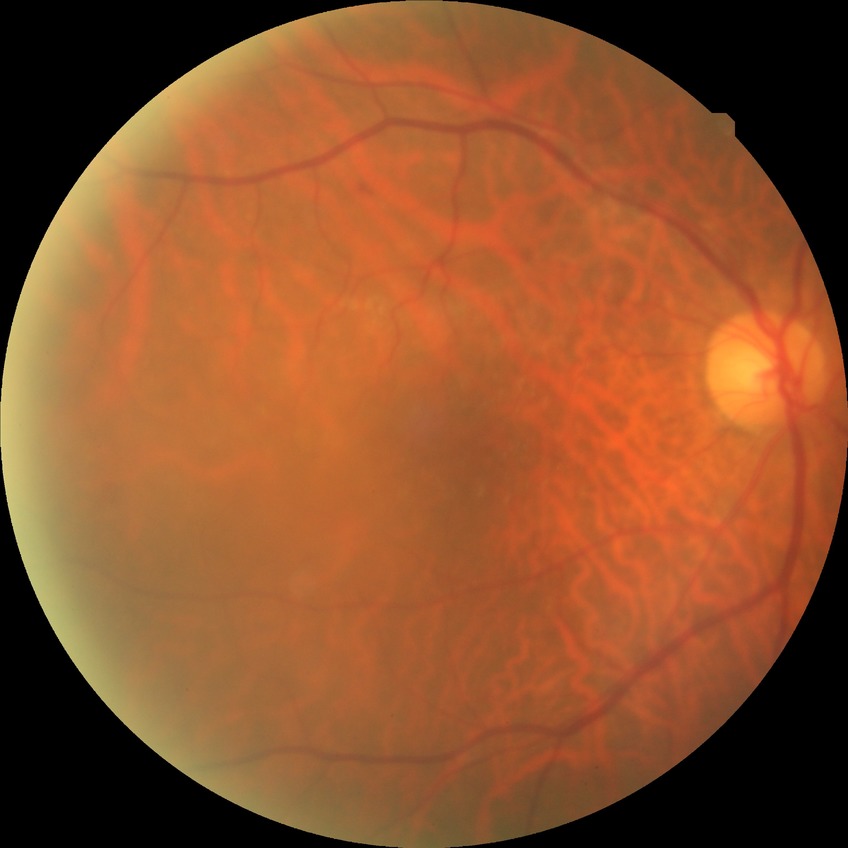
Davis grading is no diabetic retinopathy.